2048 x 1536 pixels · CFP · 45° FOV:
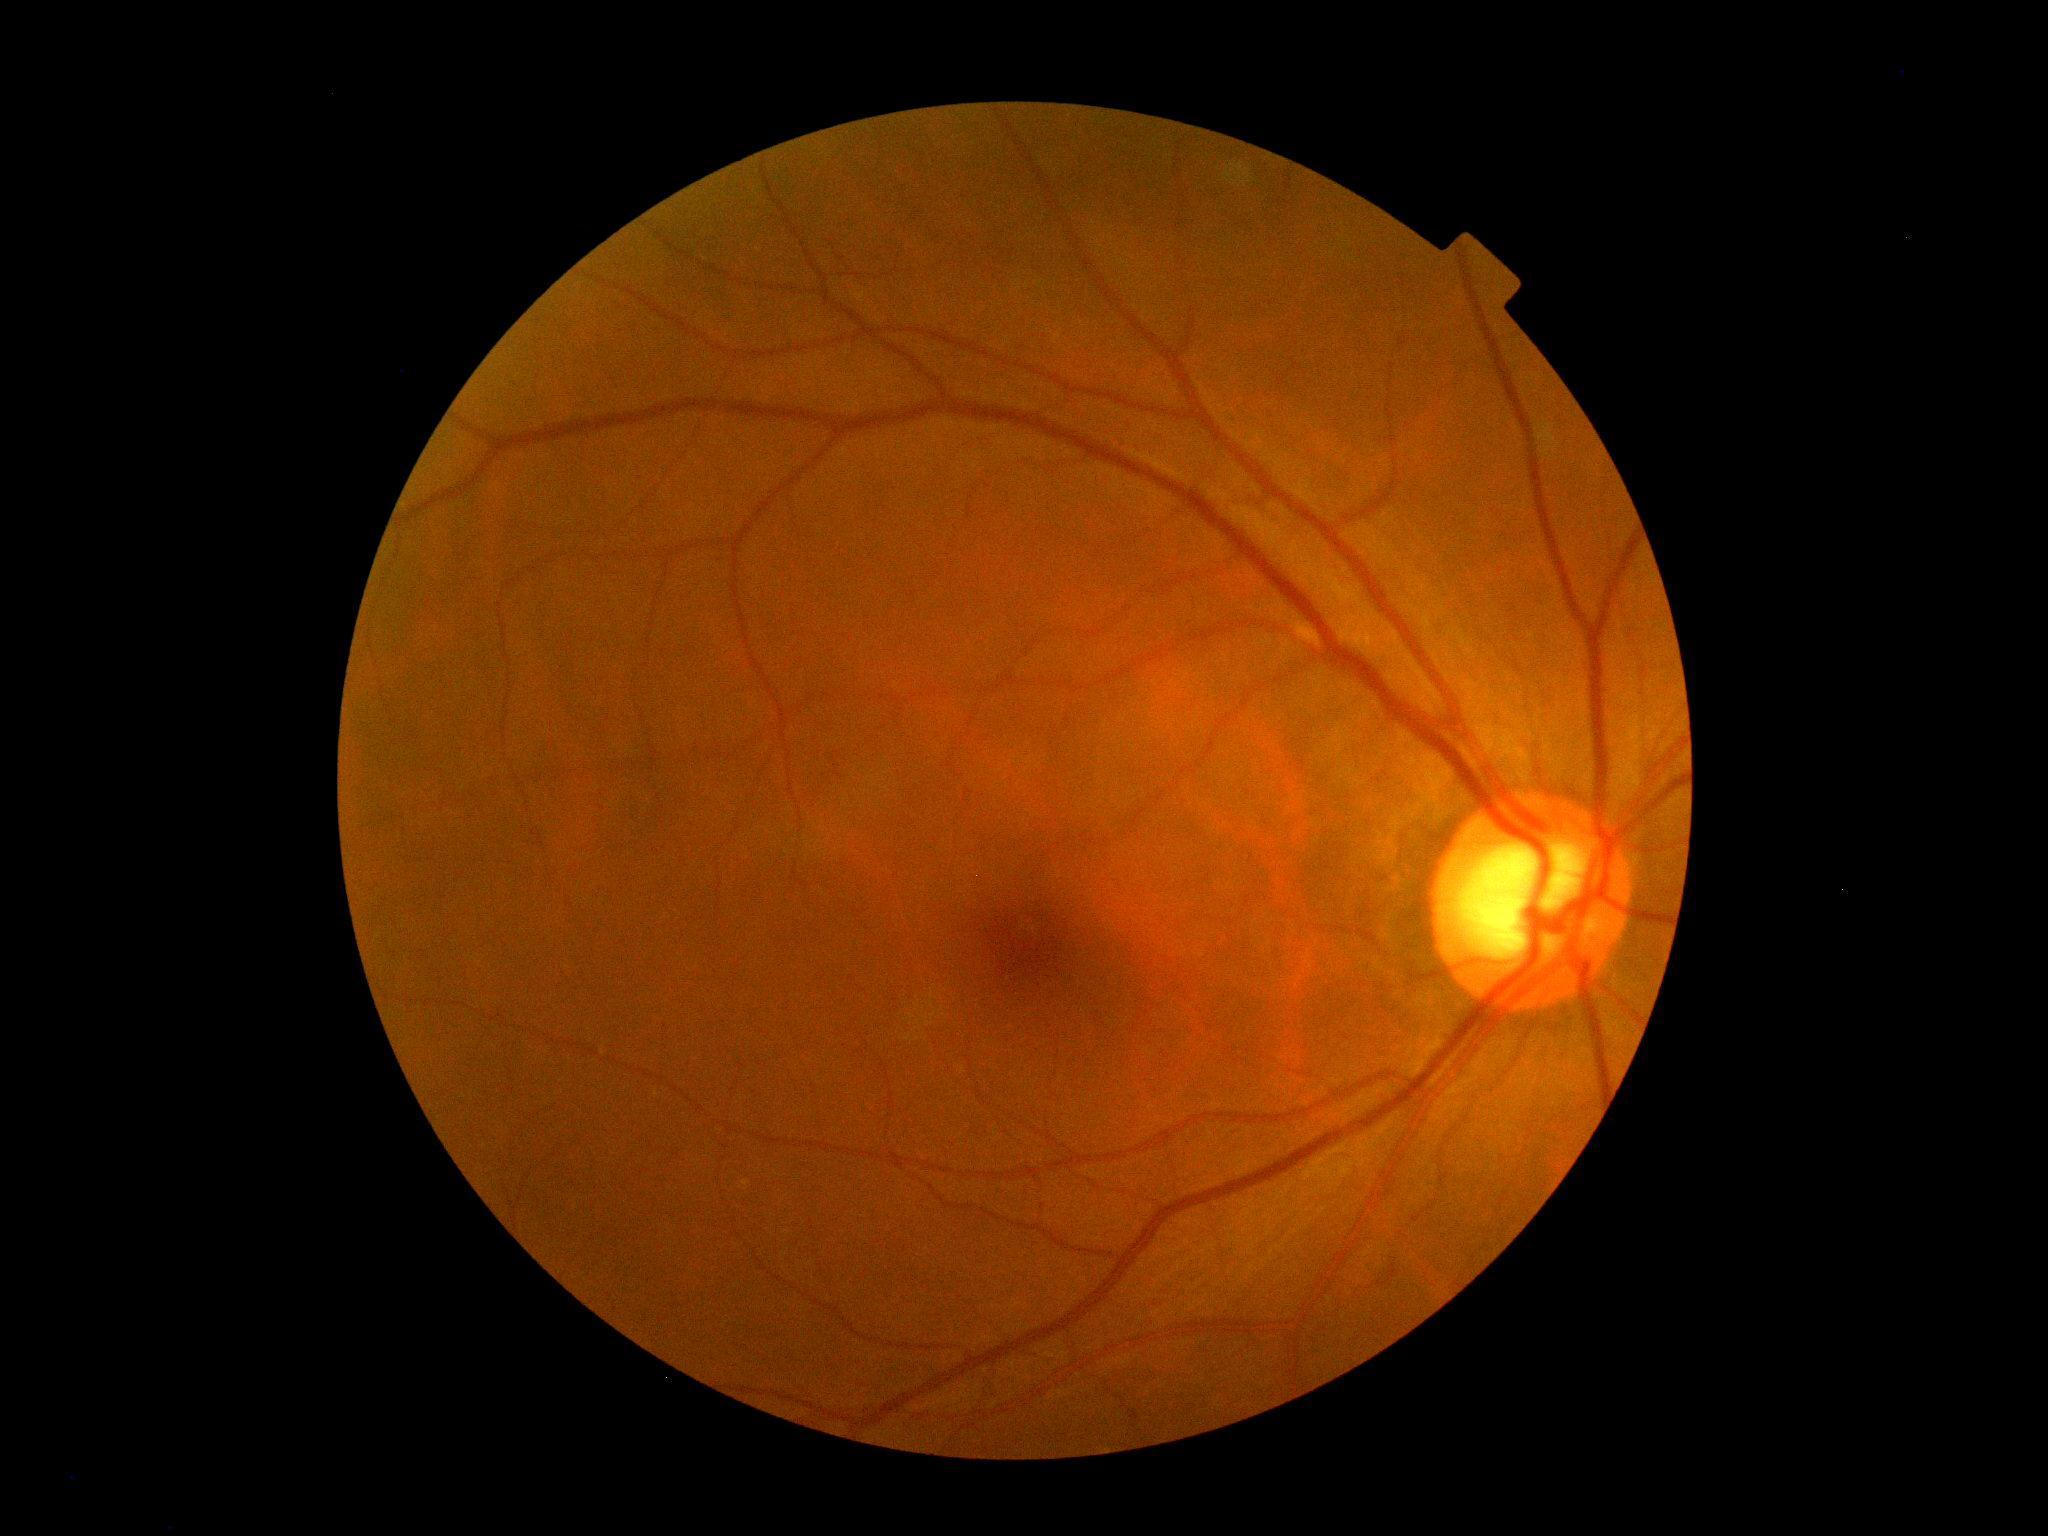
No apparent diabetic retinopathy.
DR stage: grade 0 (no apparent retinopathy) — no visible signs of diabetic retinopathy.